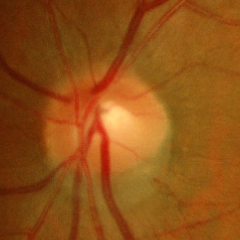

Findings consistent with no glaucomatous findings.